FOV: 45 degrees — 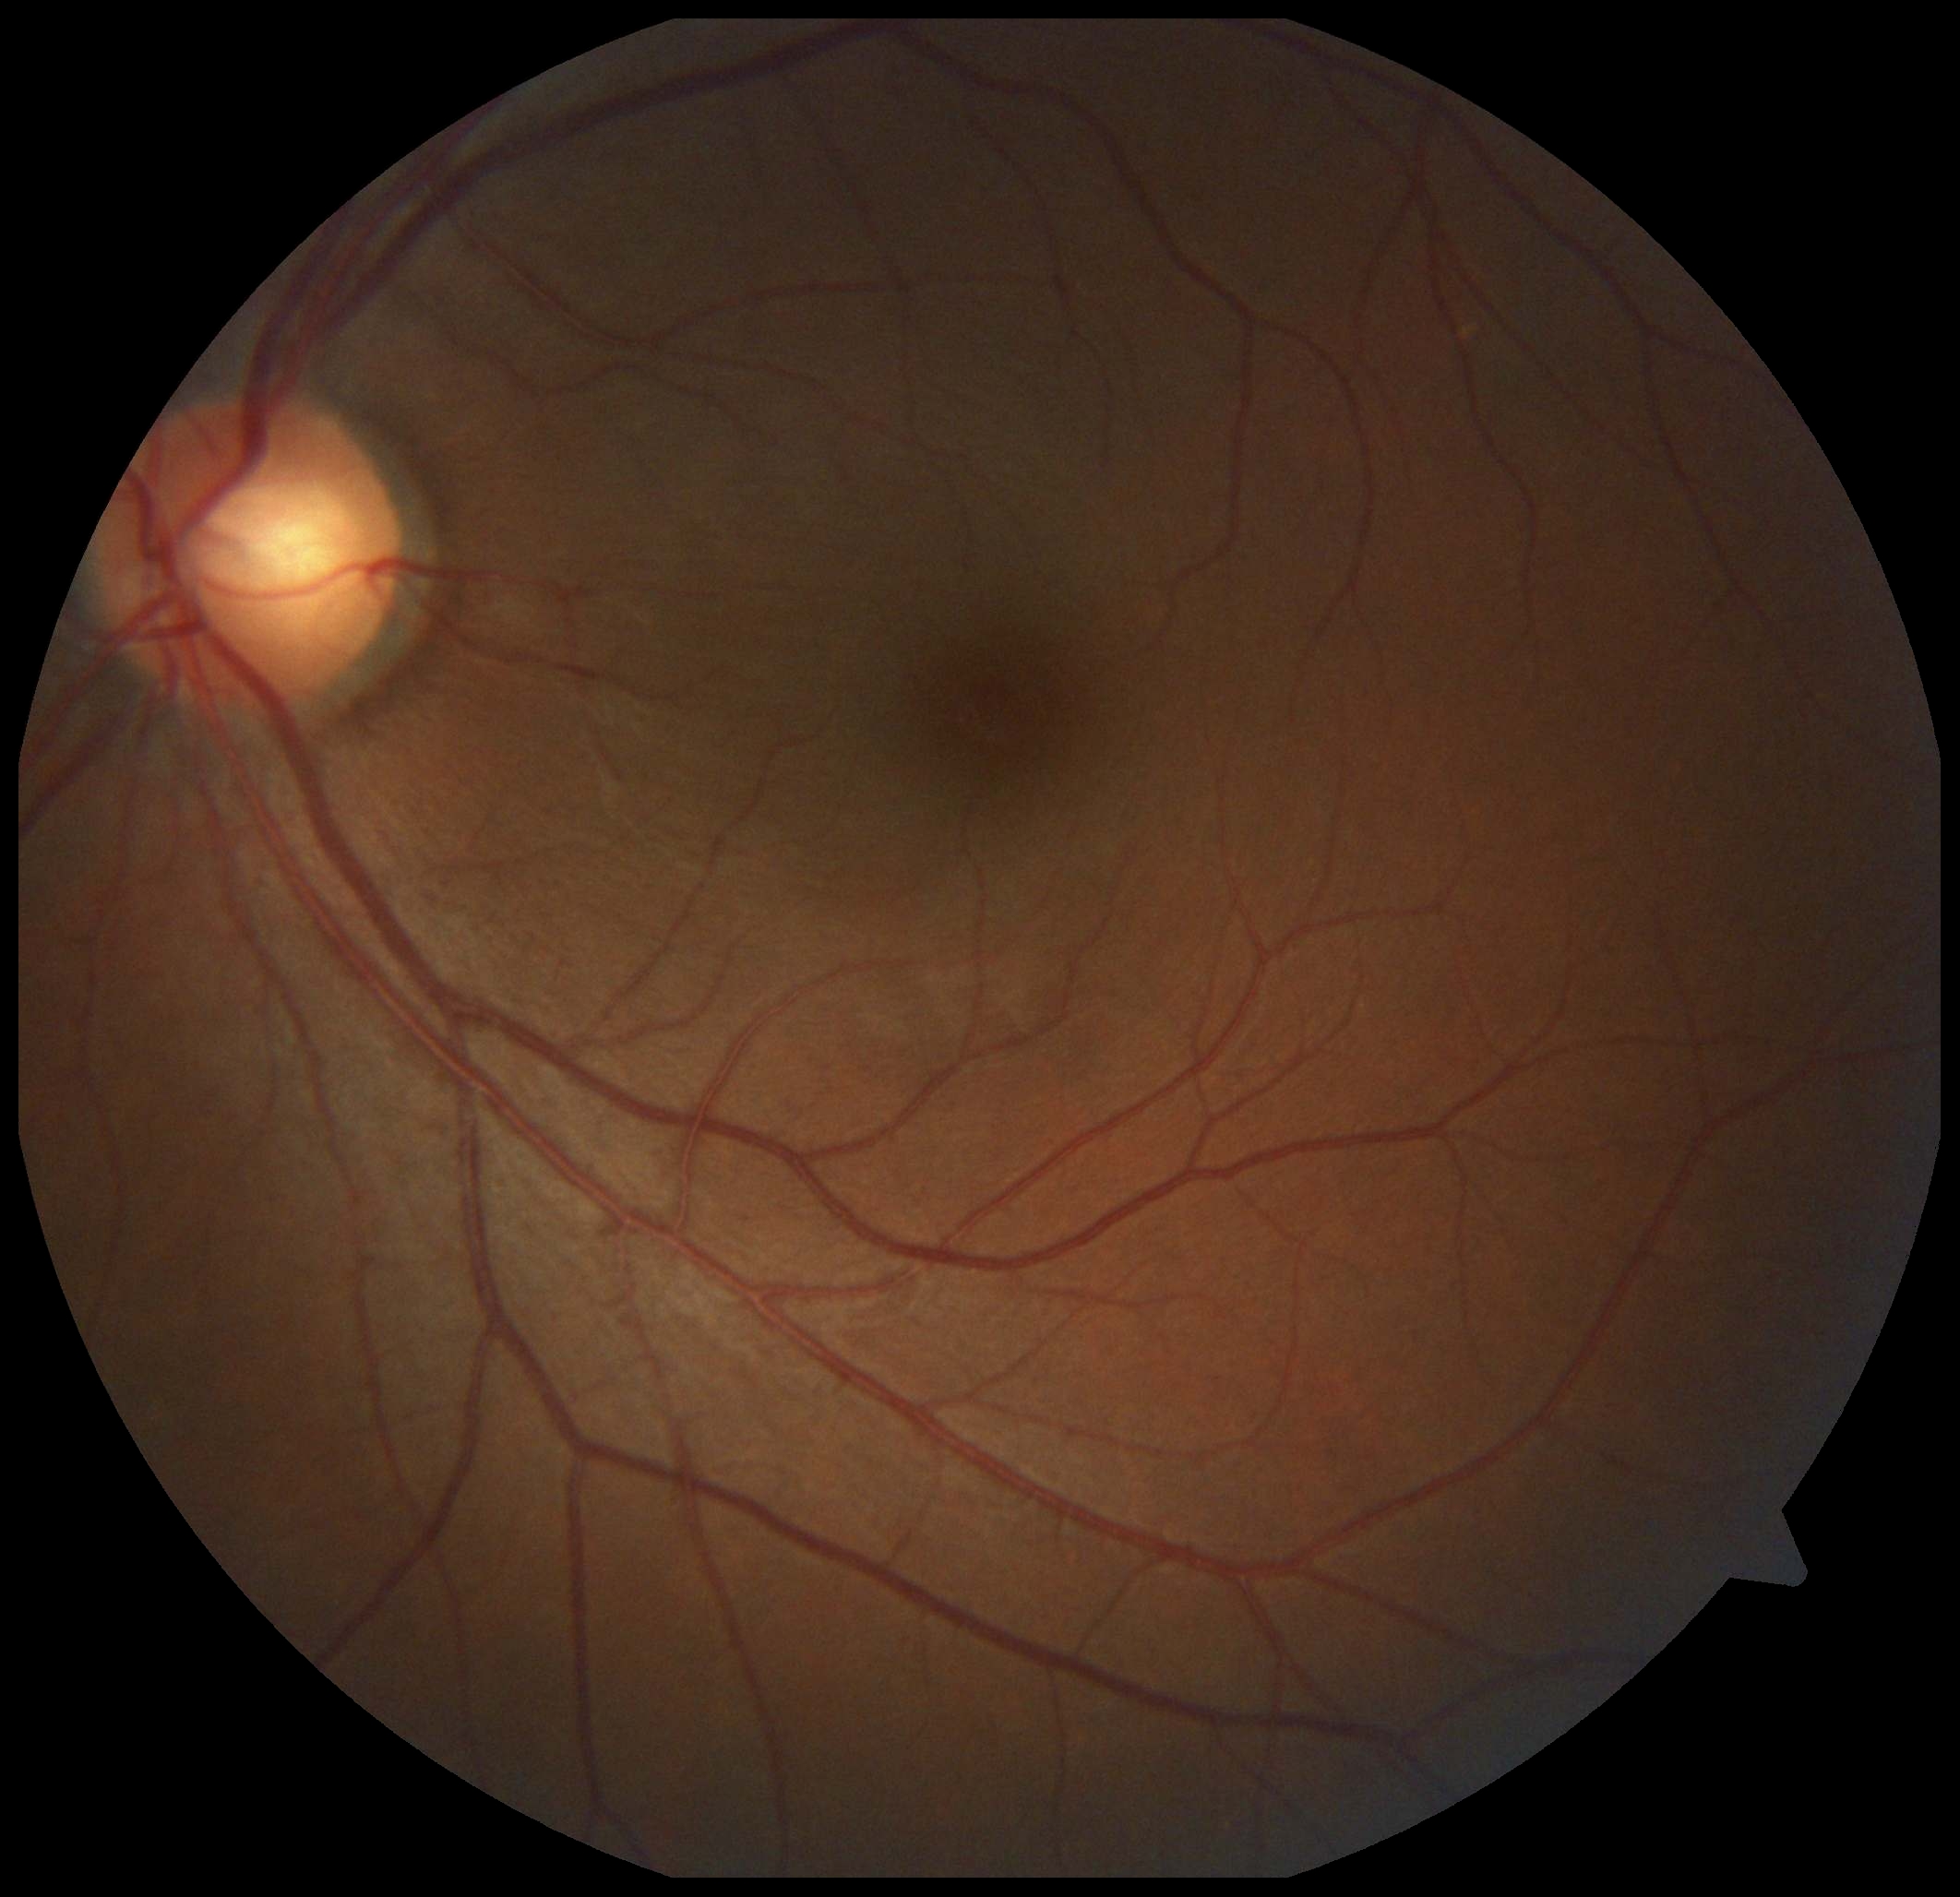

dr_grade: grade 0